FOV: 45 degrees, retinal fundus photograph — 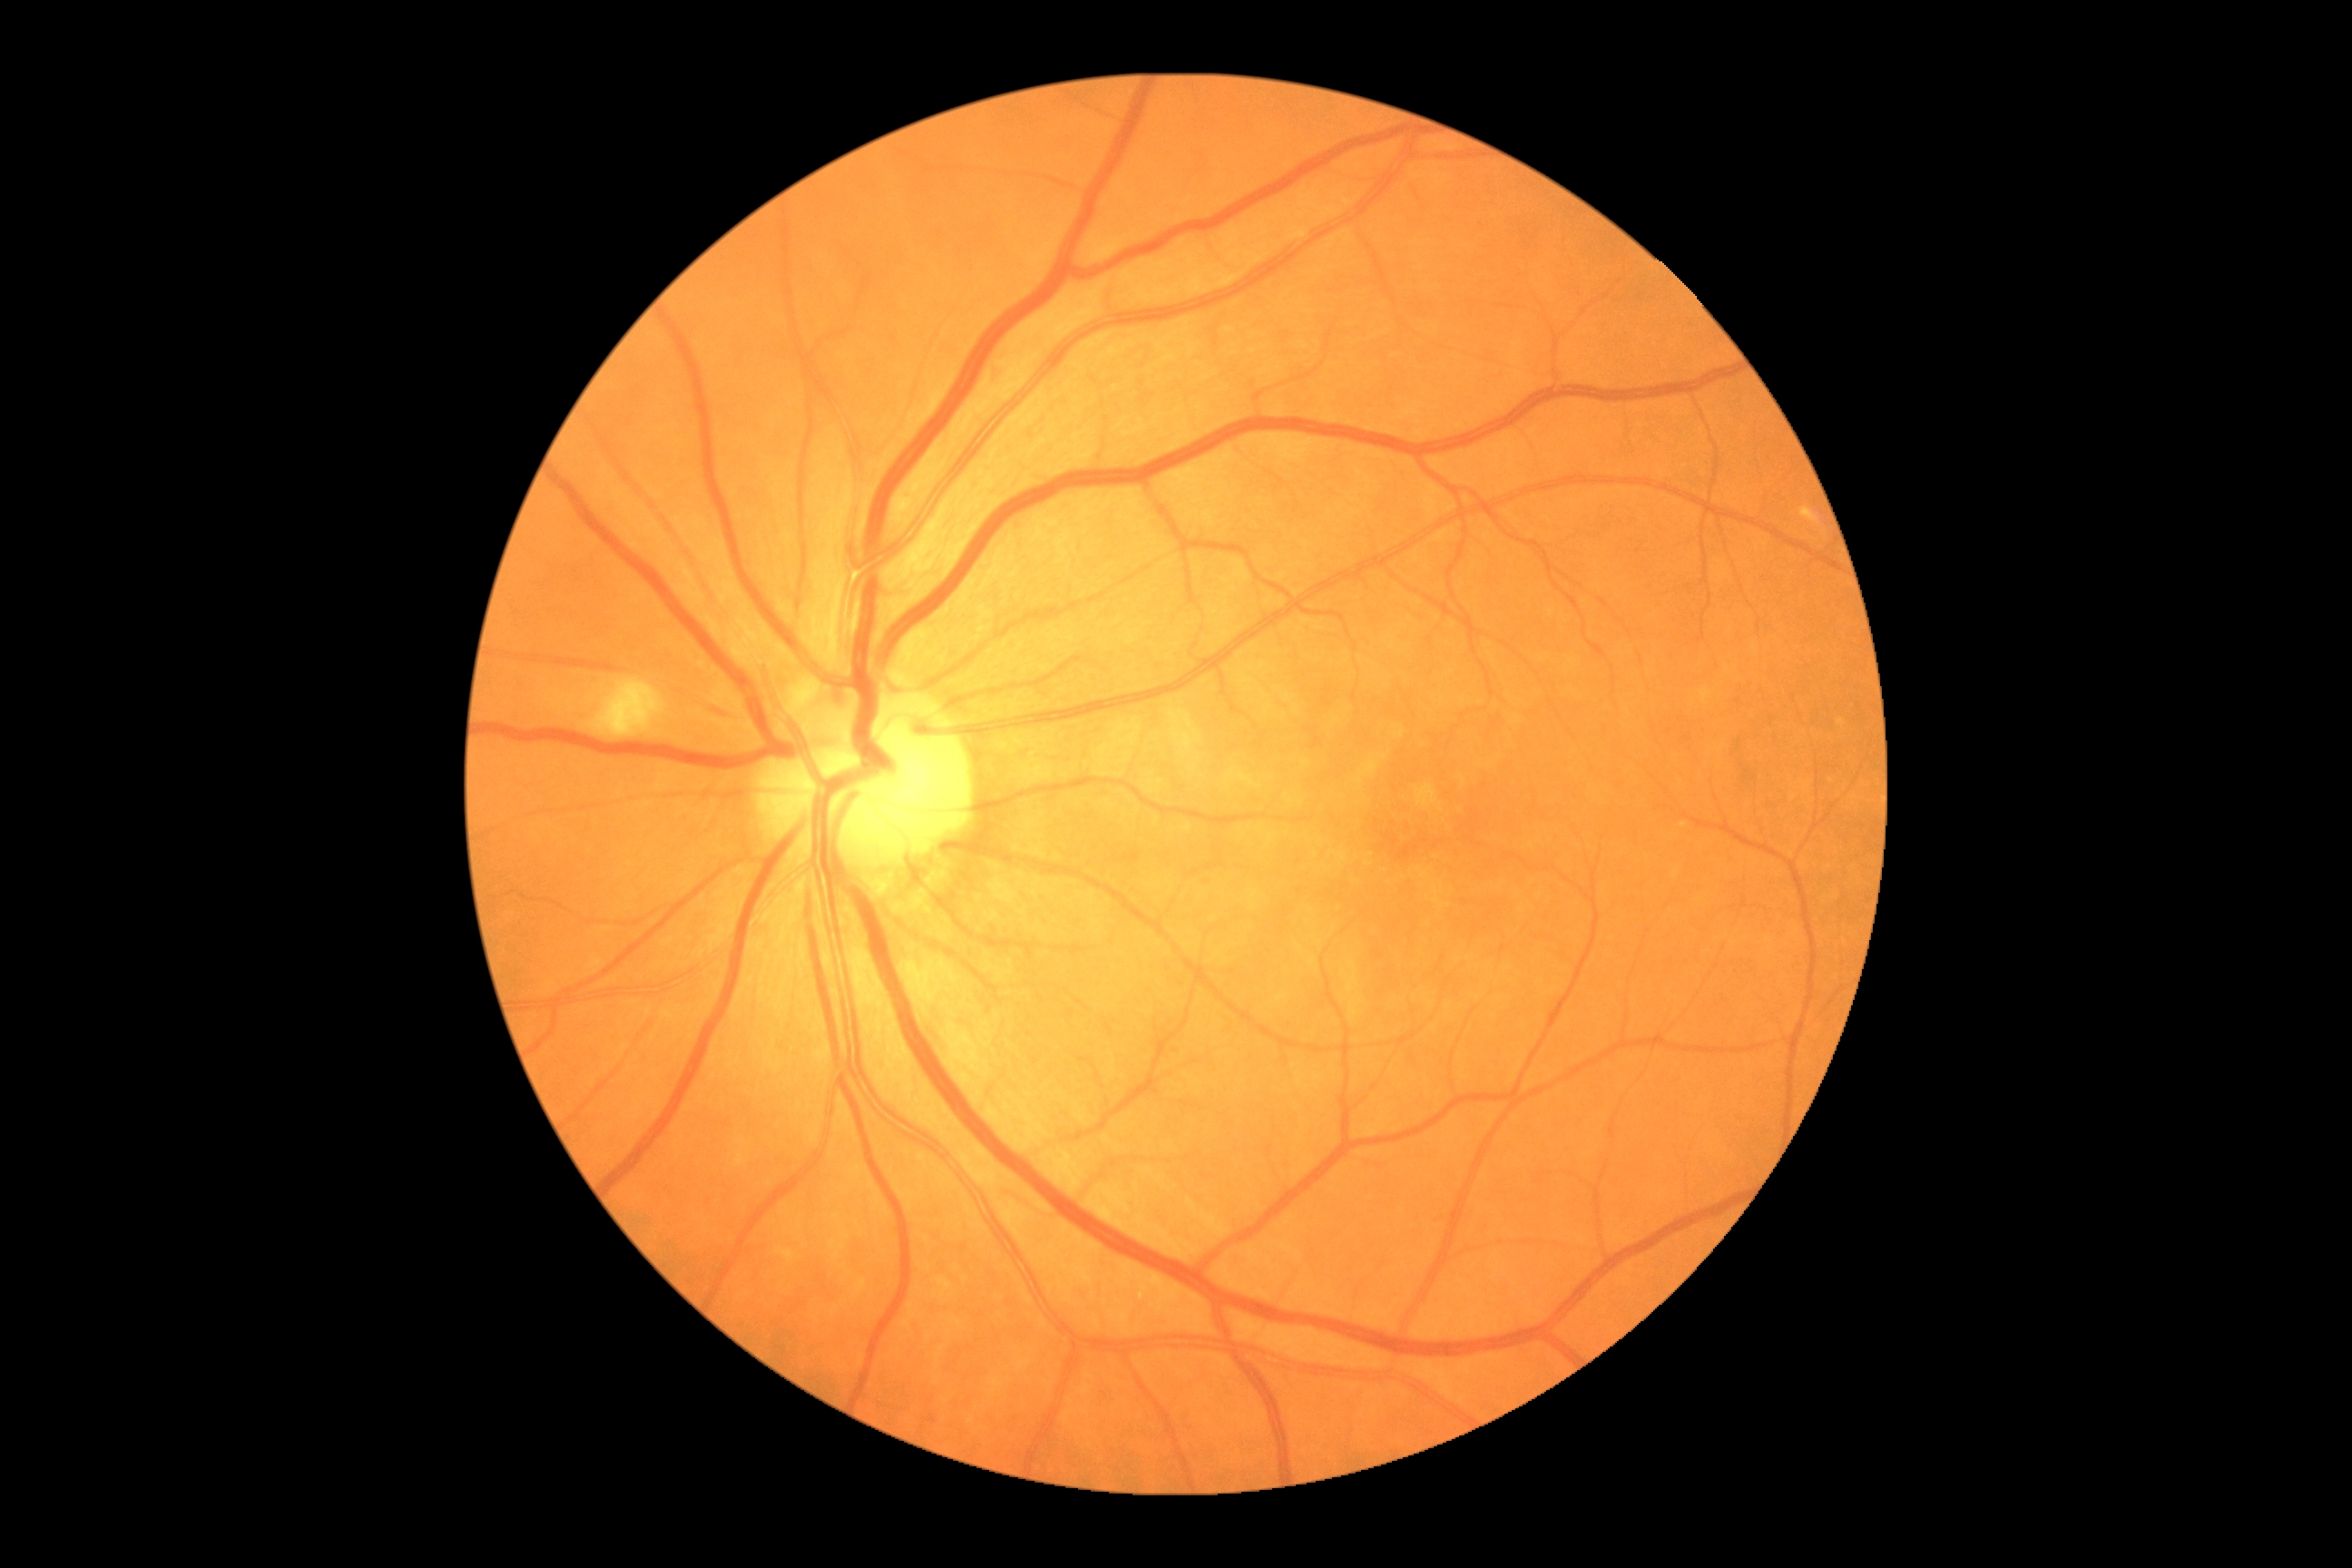 DR severity: moderate NPDR (grade 2).